Color fundus image. 1932 x 1910 pixels. 45-degree field of view: 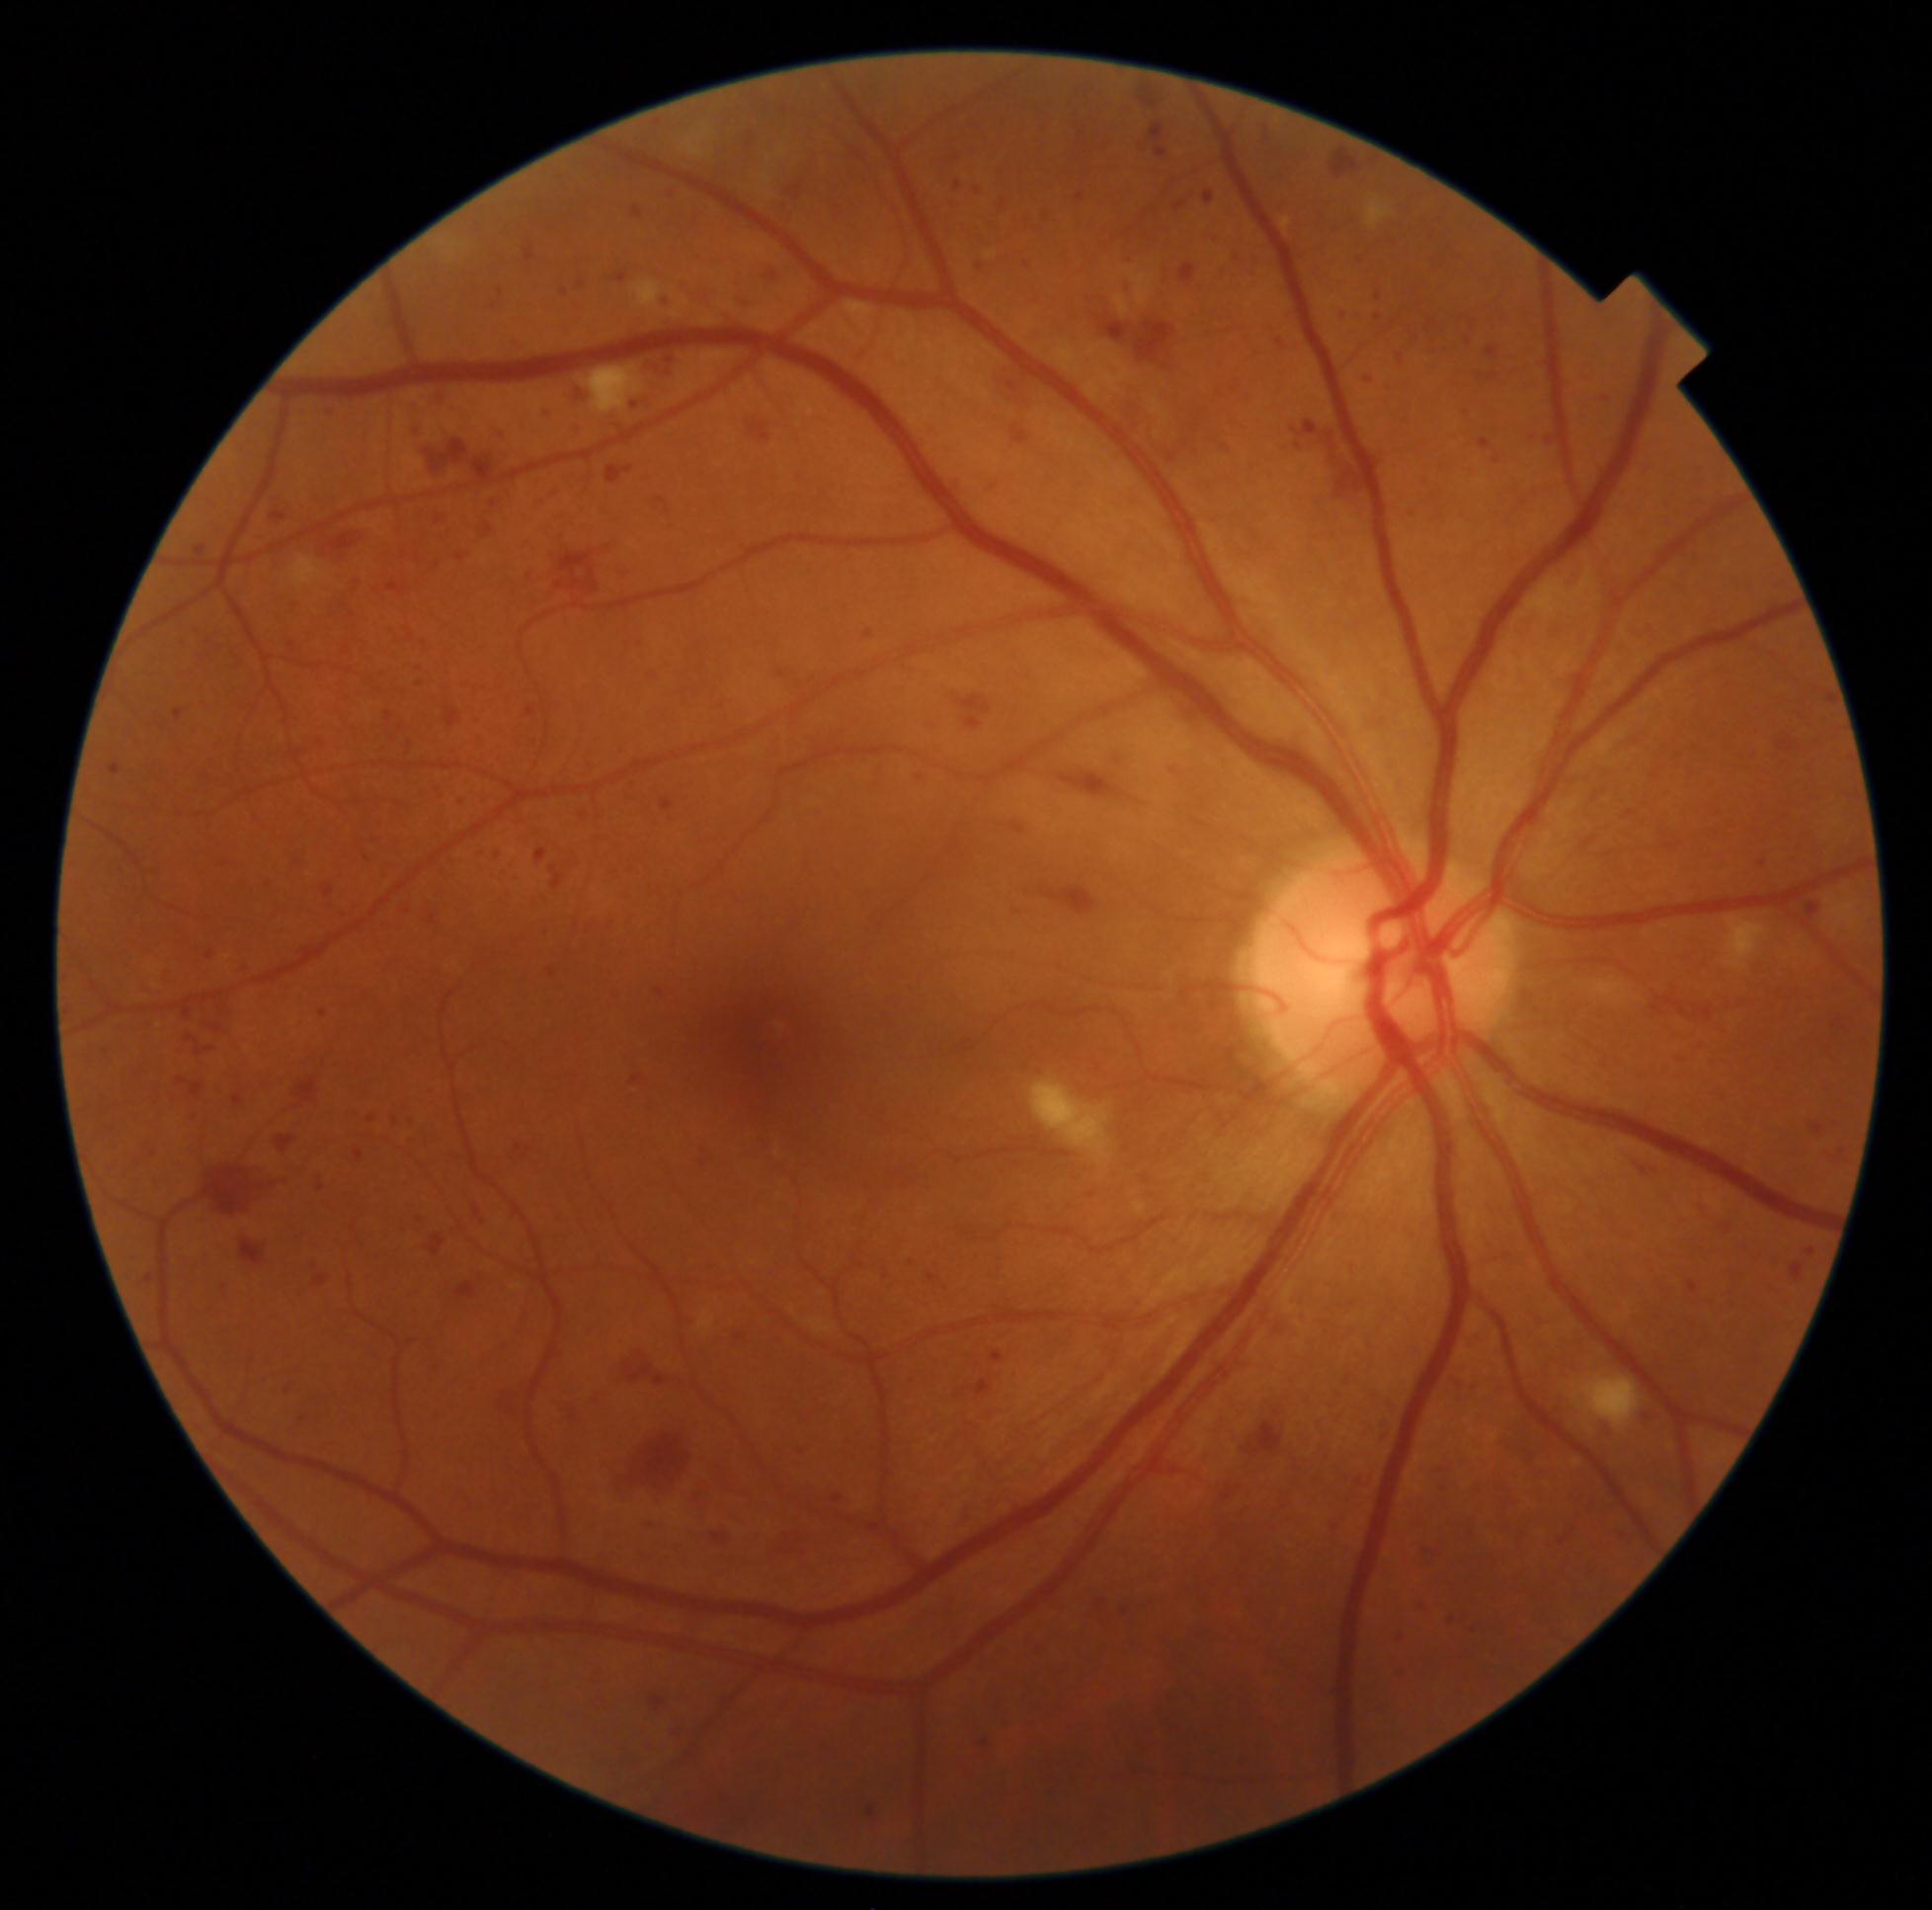 DR: 3 — more than 20 intraretinal hemorrhages in each of 4 quadrants, definite venous beading in 2 or more quadrants, or prominent intraretinal microvascular abnormalities in 1 or more quadrants, with no signs of proliferative retinopathy
Selected lesions:
- HEs (partial): {"left": 1463, "top": 1321, "right": 1494, "bottom": 1354} | {"left": 216, "top": 1283, "right": 232, "bottom": 1303} | {"left": 289, "top": 597, "right": 305, "bottom": 619} | {"left": 1346, "top": 1375, "right": 1352, "bottom": 1386} | {"left": 400, "top": 1181, "right": 413, "bottom": 1190} | {"left": 1127, "top": 208, "right": 1171, "bottom": 253} | {"left": 177, "top": 932, "right": 193, "bottom": 945} | {"left": 227, "top": 649, "right": 247, "bottom": 671} | {"left": 132, "top": 737, "right": 146, "bottom": 748} | {"left": 404, "top": 1288, "right": 427, "bottom": 1301} | {"left": 257, "top": 1077, "right": 274, "bottom": 1091} | {"left": 623, "top": 1072, "right": 648, "bottom": 1098} | {"left": 1084, "top": 292, "right": 1182, "bottom": 372} | {"left": 347, "top": 452, "right": 361, "bottom": 471} | {"left": 621, "top": 779, "right": 637, "bottom": 804} | {"left": 1391, "top": 460, "right": 1404, "bottom": 474} | {"left": 285, "top": 856, "right": 312, "bottom": 876} | {"left": 637, "top": 640, "right": 650, "bottom": 651}
- Additional small HEs near 921/778 | 1423/1608